Ultra-widefield fundus mosaic:
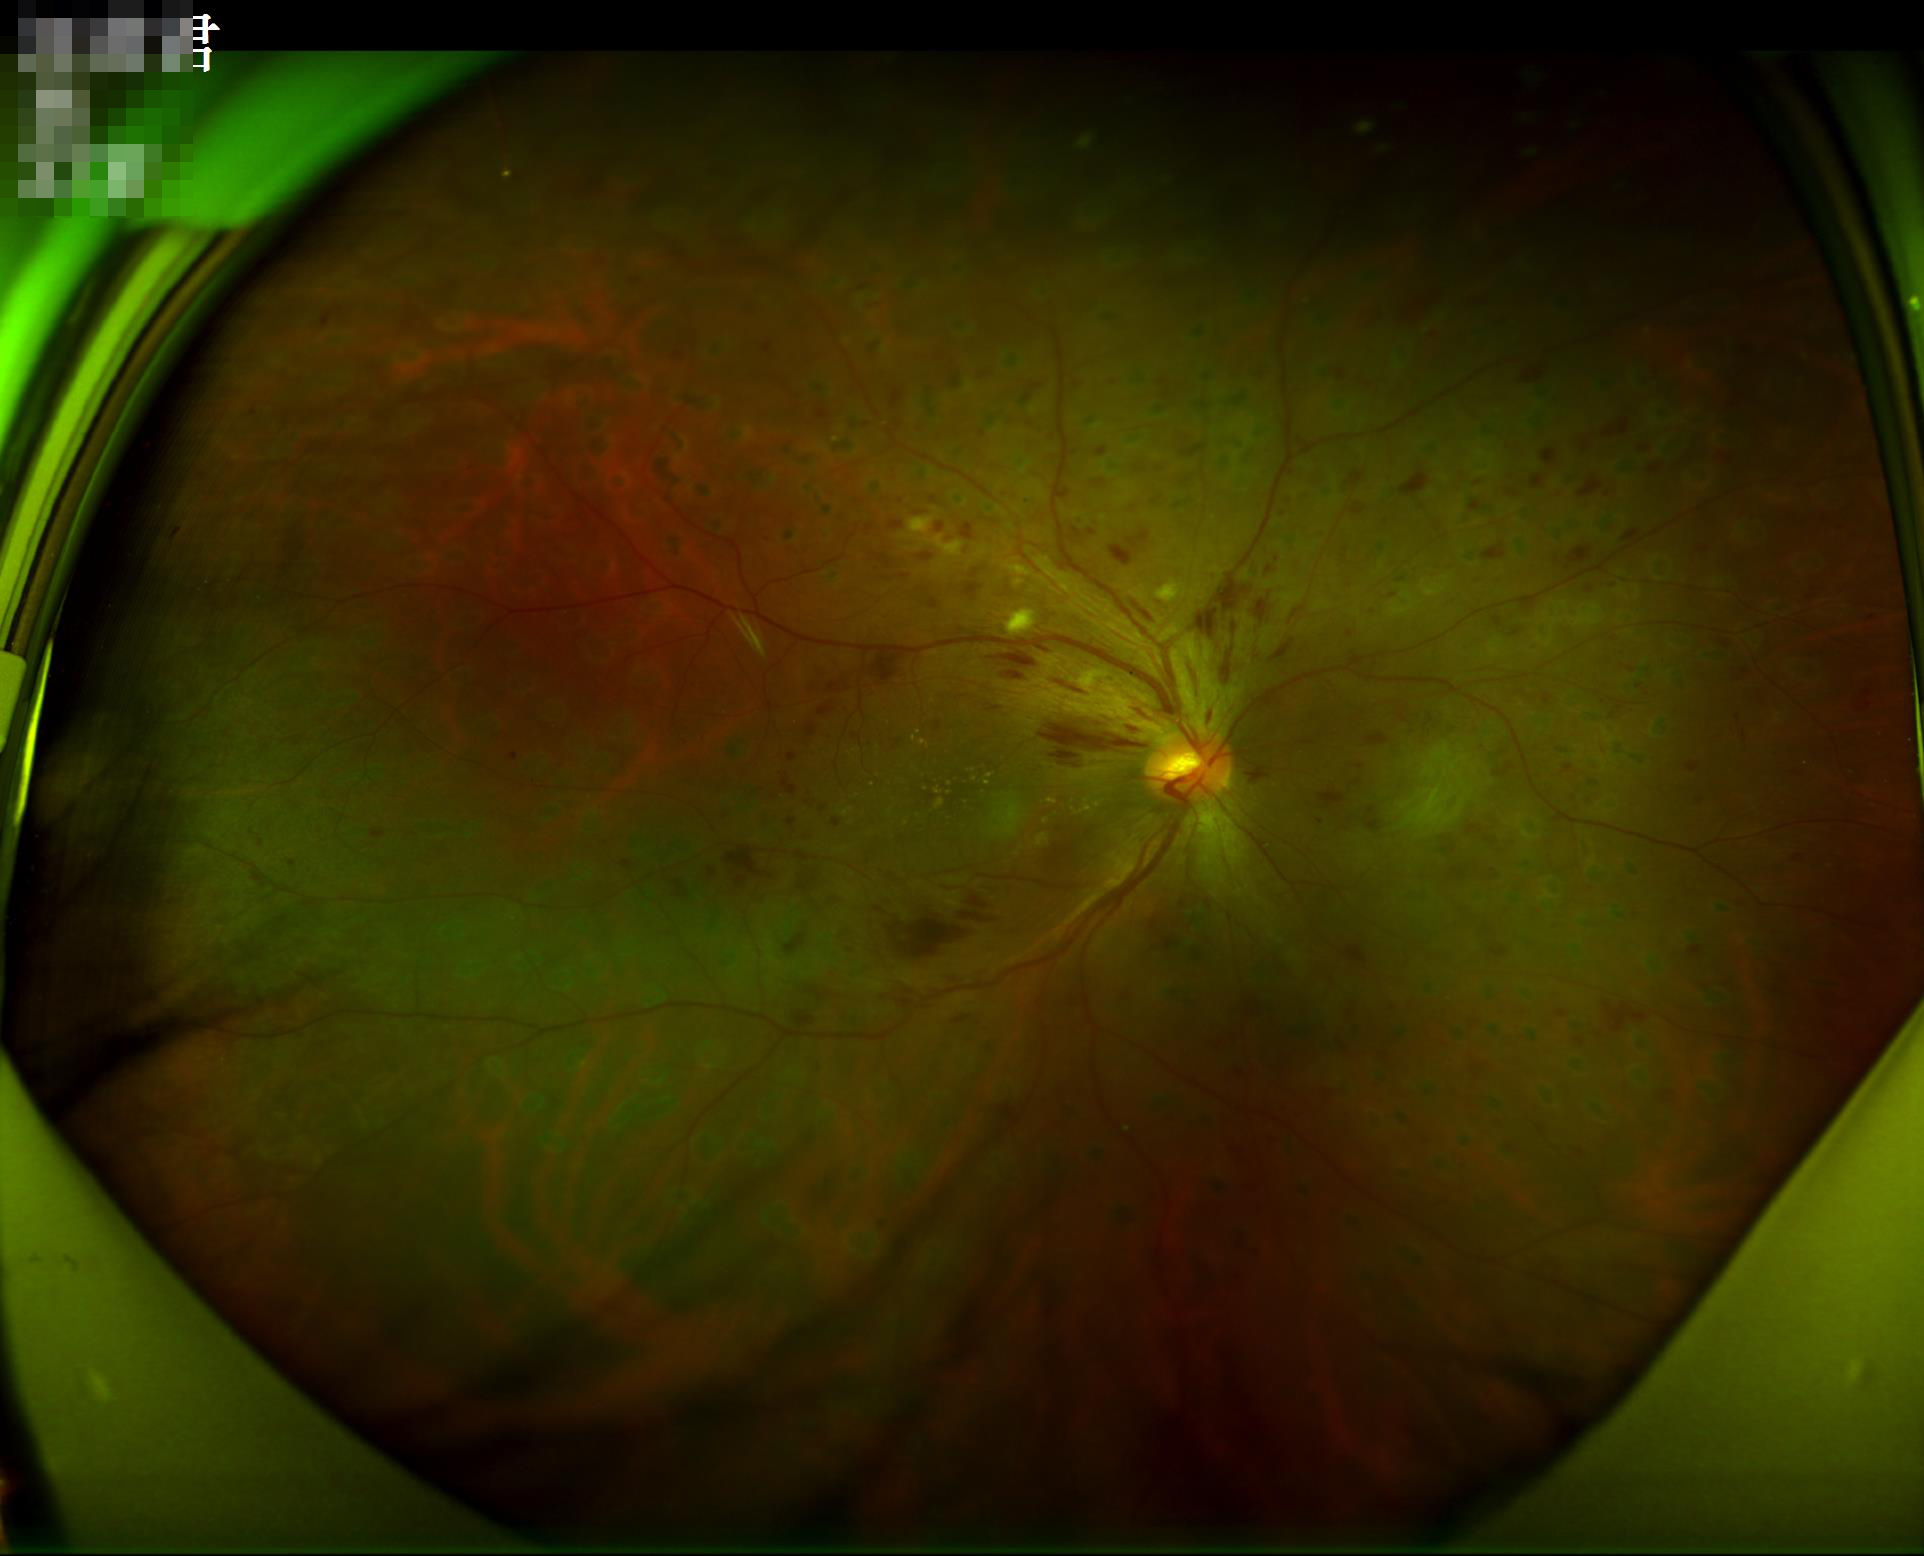

Quality grading: overall: adequate for clinical interpretation; contrast: wide intensity range, structures distinguishable; clarity: optic disc, vessels, and background in focus; illumination/color: over- or under-exposed.